CFP
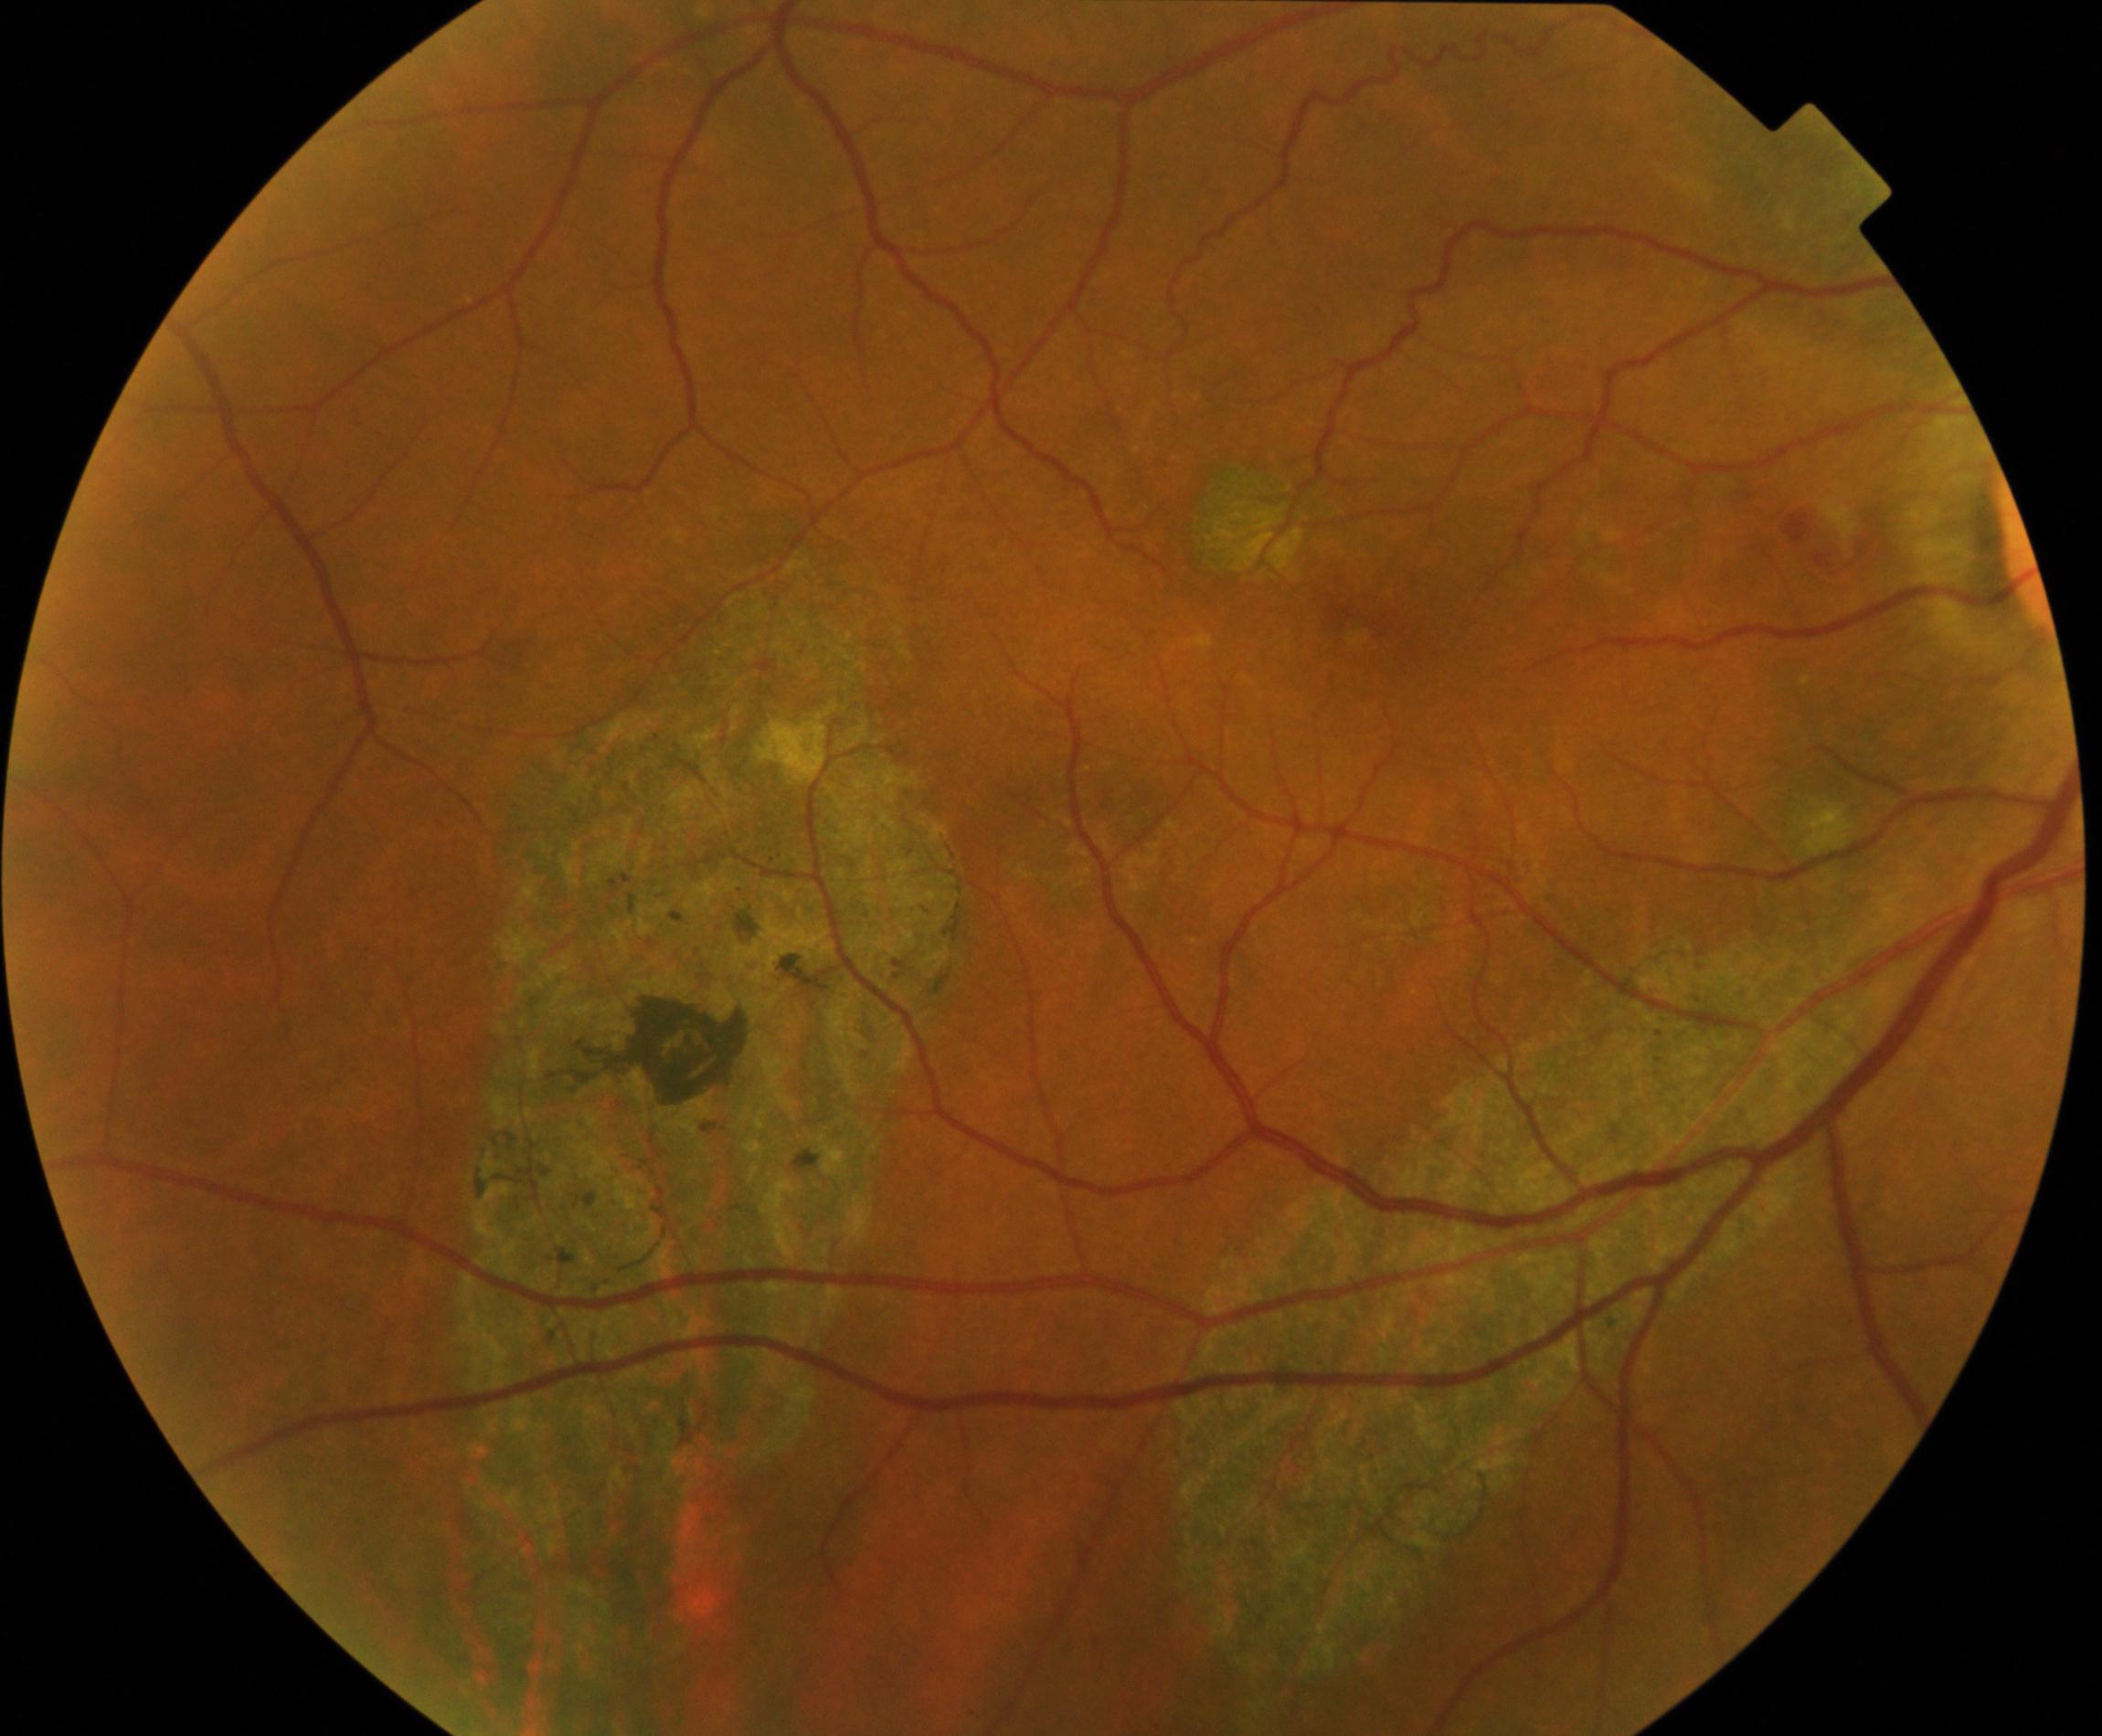 Diagnosis: chorioretinal atrophy or coloboma.